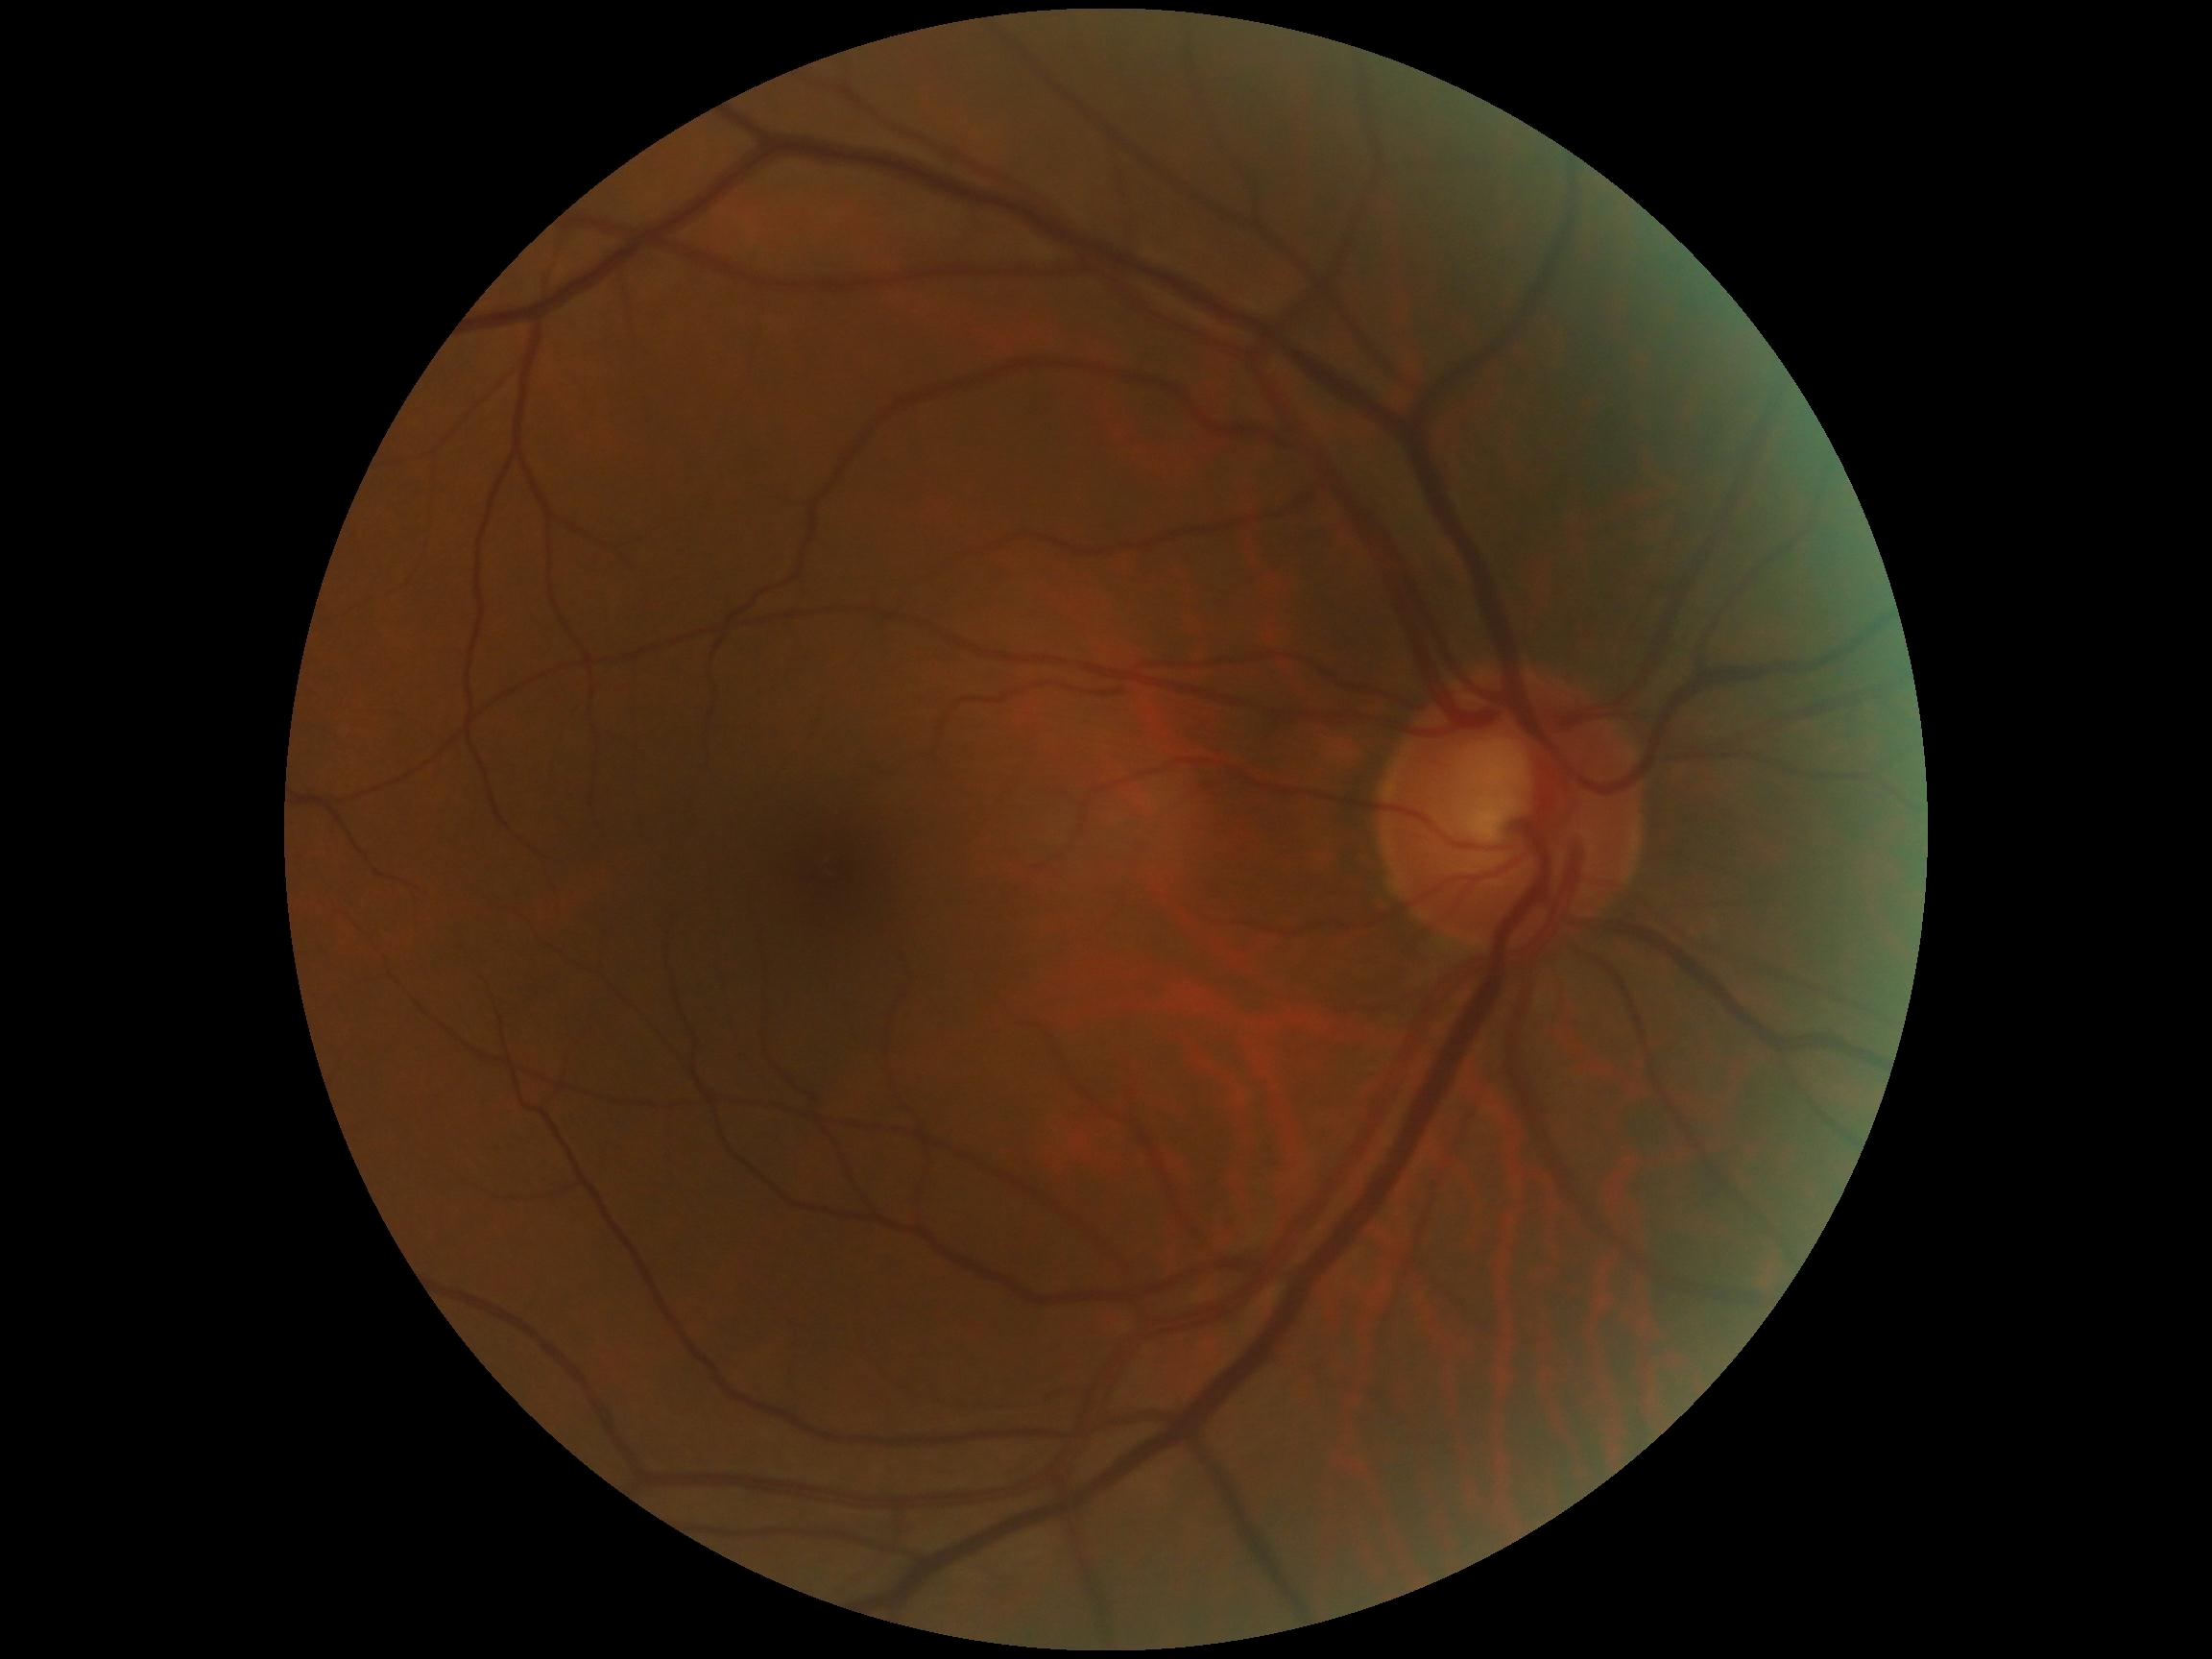
Diabetic retinopathy (DR) is no apparent diabetic retinopathy (grade 0).